Color fundus image. NIDEK AFC-230 fundus camera. FOV: 45 degrees. Davis DR grading. Nonmydriatic fundus photograph — 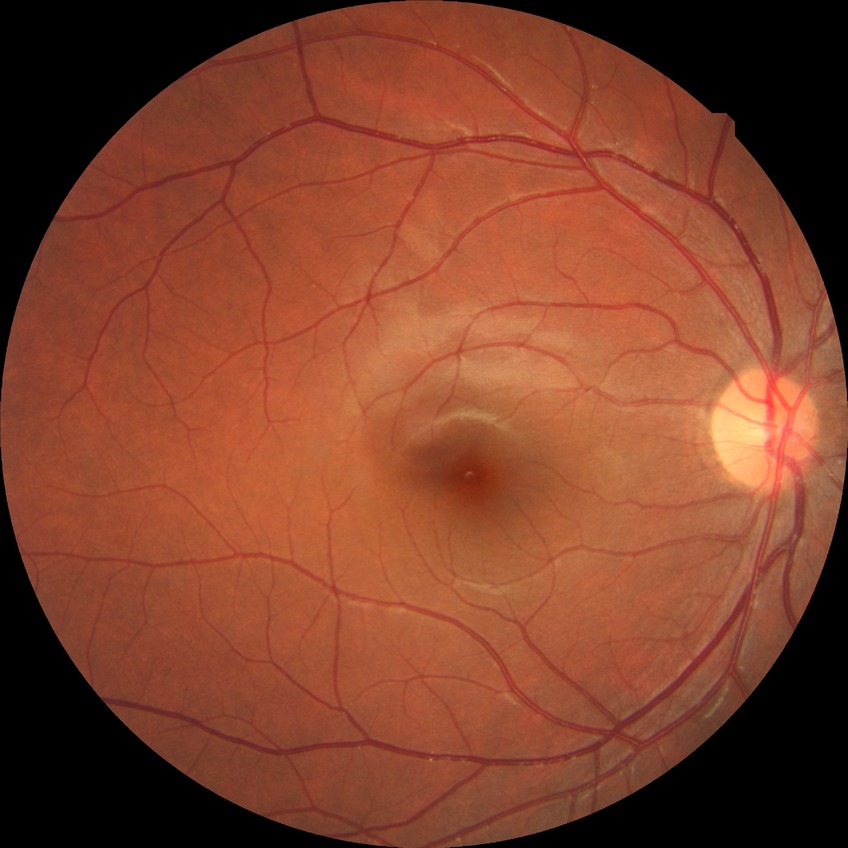
Diabetic retinopathy (DR): NDR (no diabetic retinopathy).